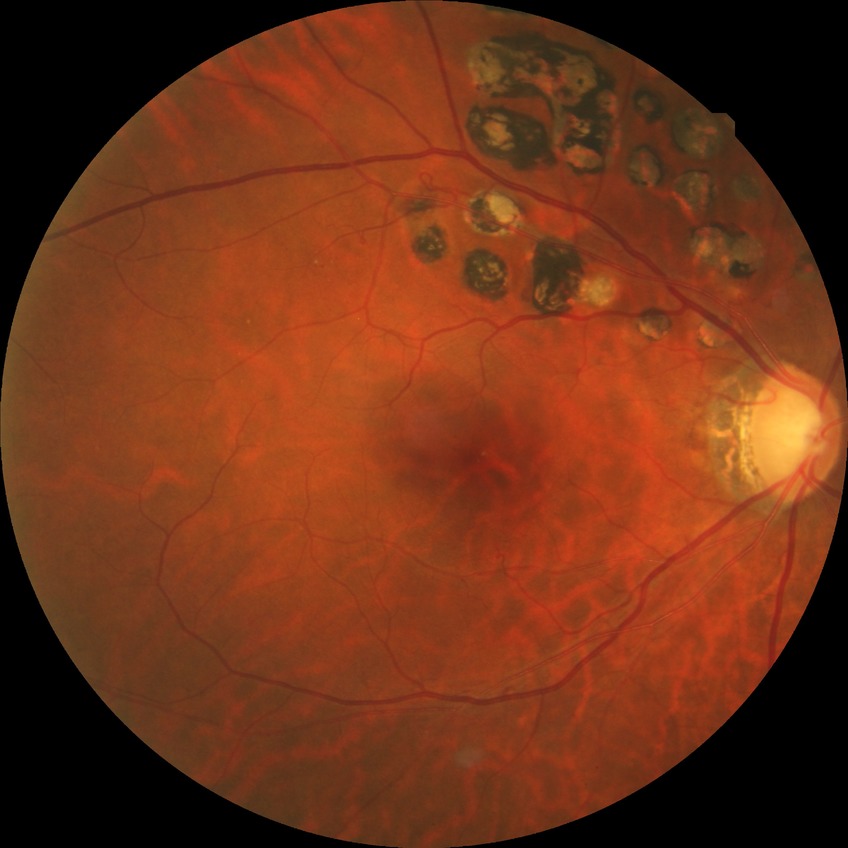 Davis stage is PDR.